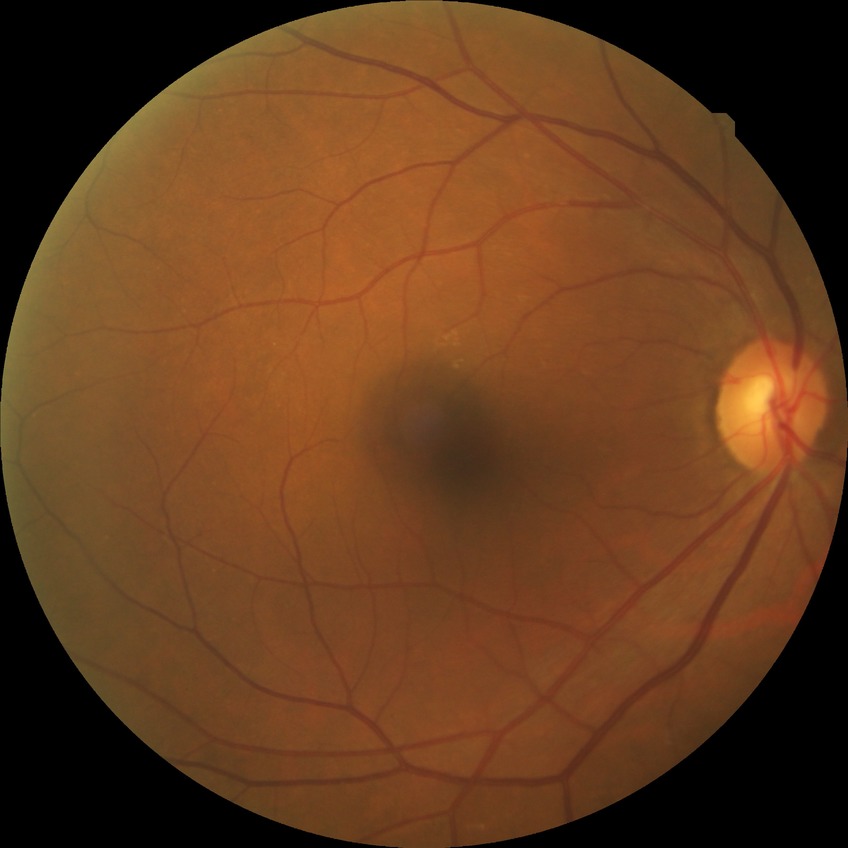

DR: NDR.